CFP · 45-degree field of view · 1470 x 1137 pixels — 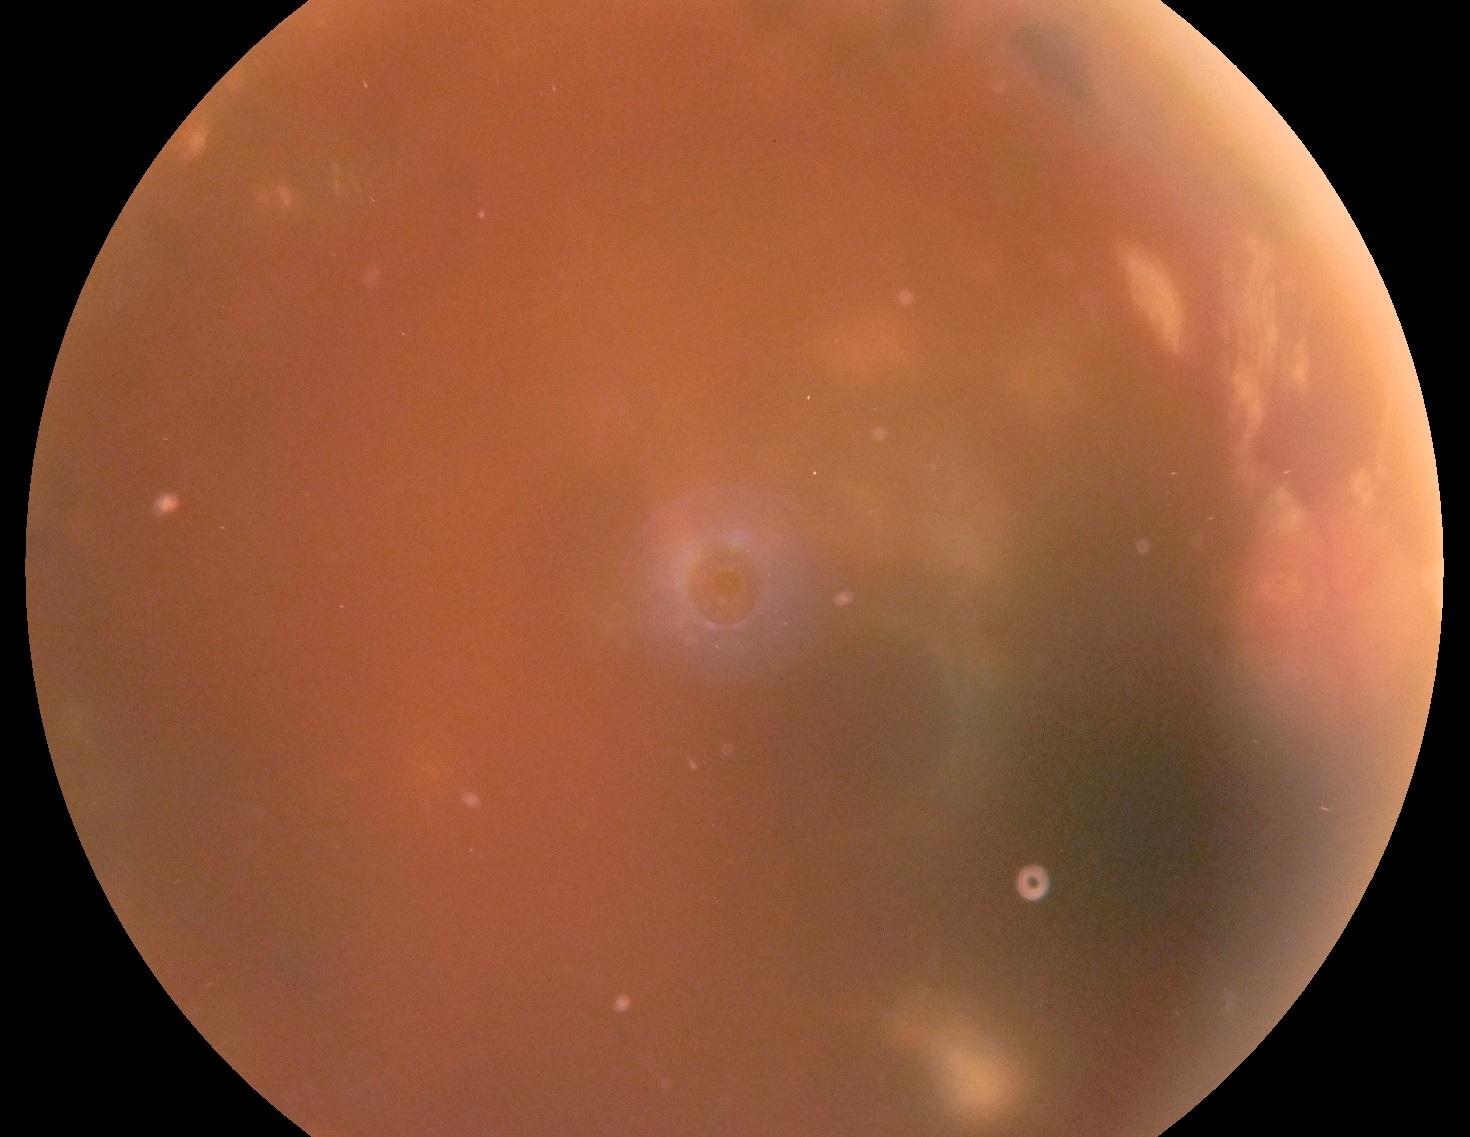
DR grade is ungradable due to poor image quality. Ungradable image — DR severity cannot be determined.